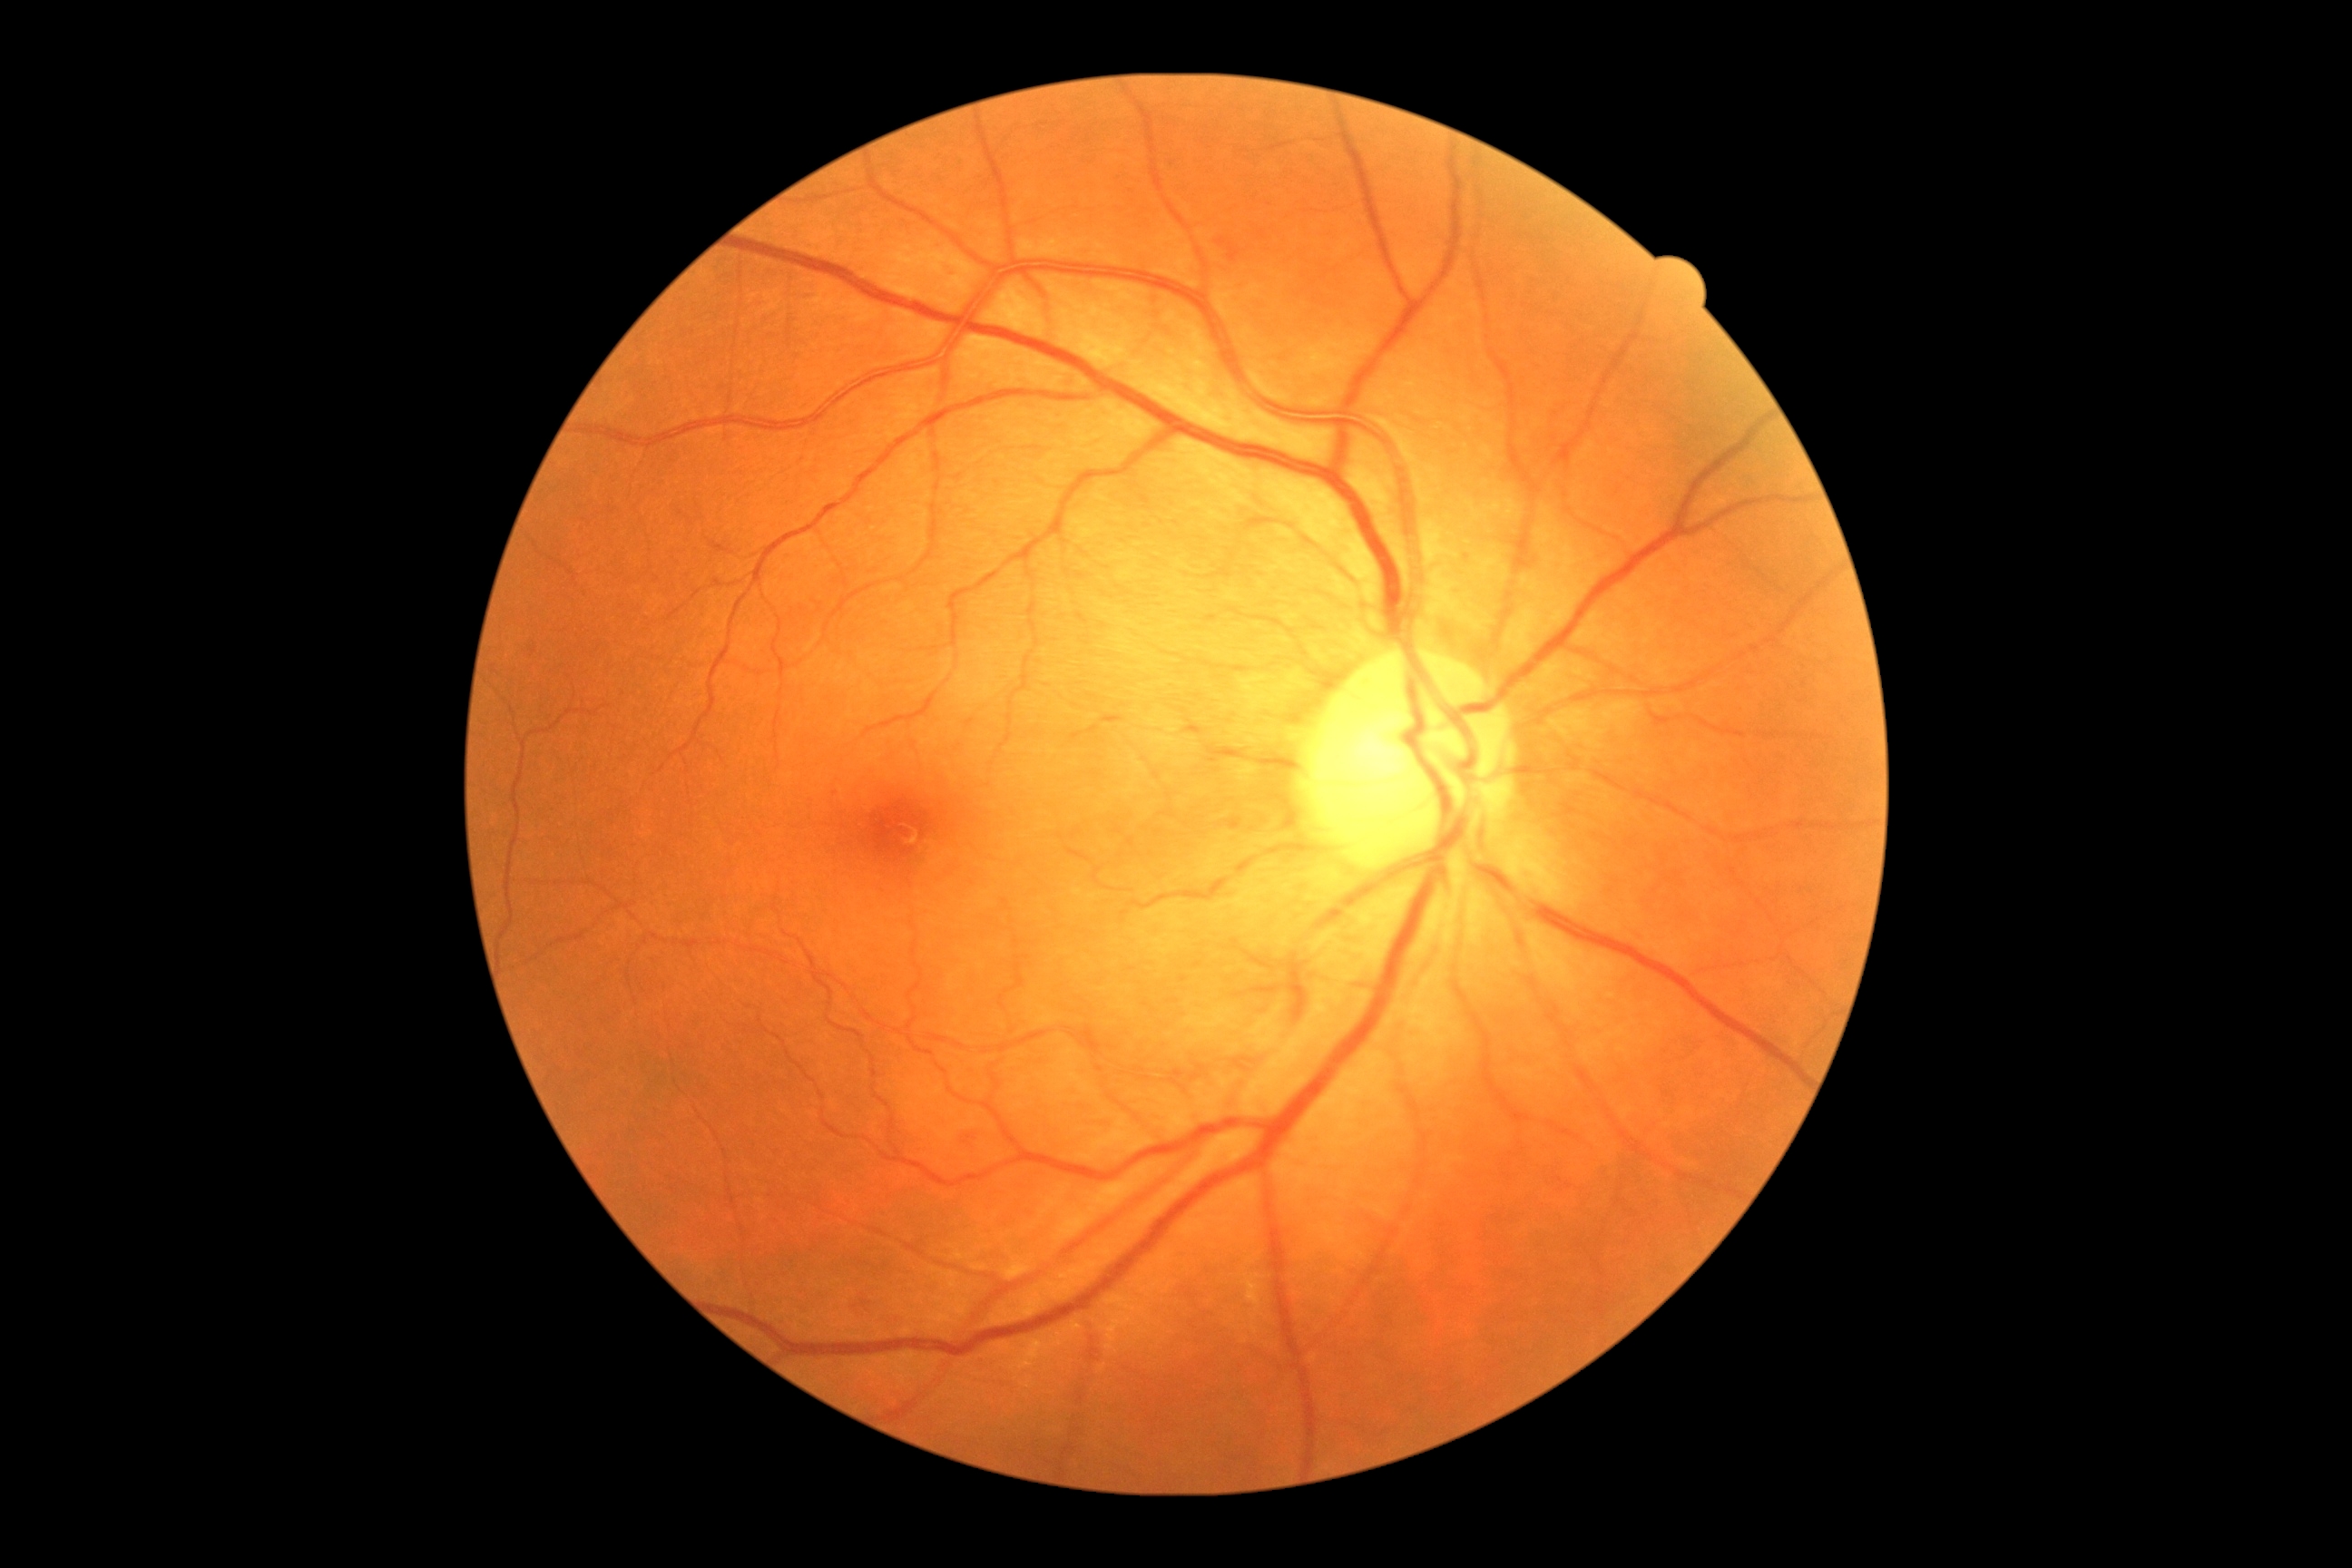
DR stage is moderate NPDR (grade 2). Disease class: non-proliferative diabetic retinopathy.